2184x1690. 45° FOV: 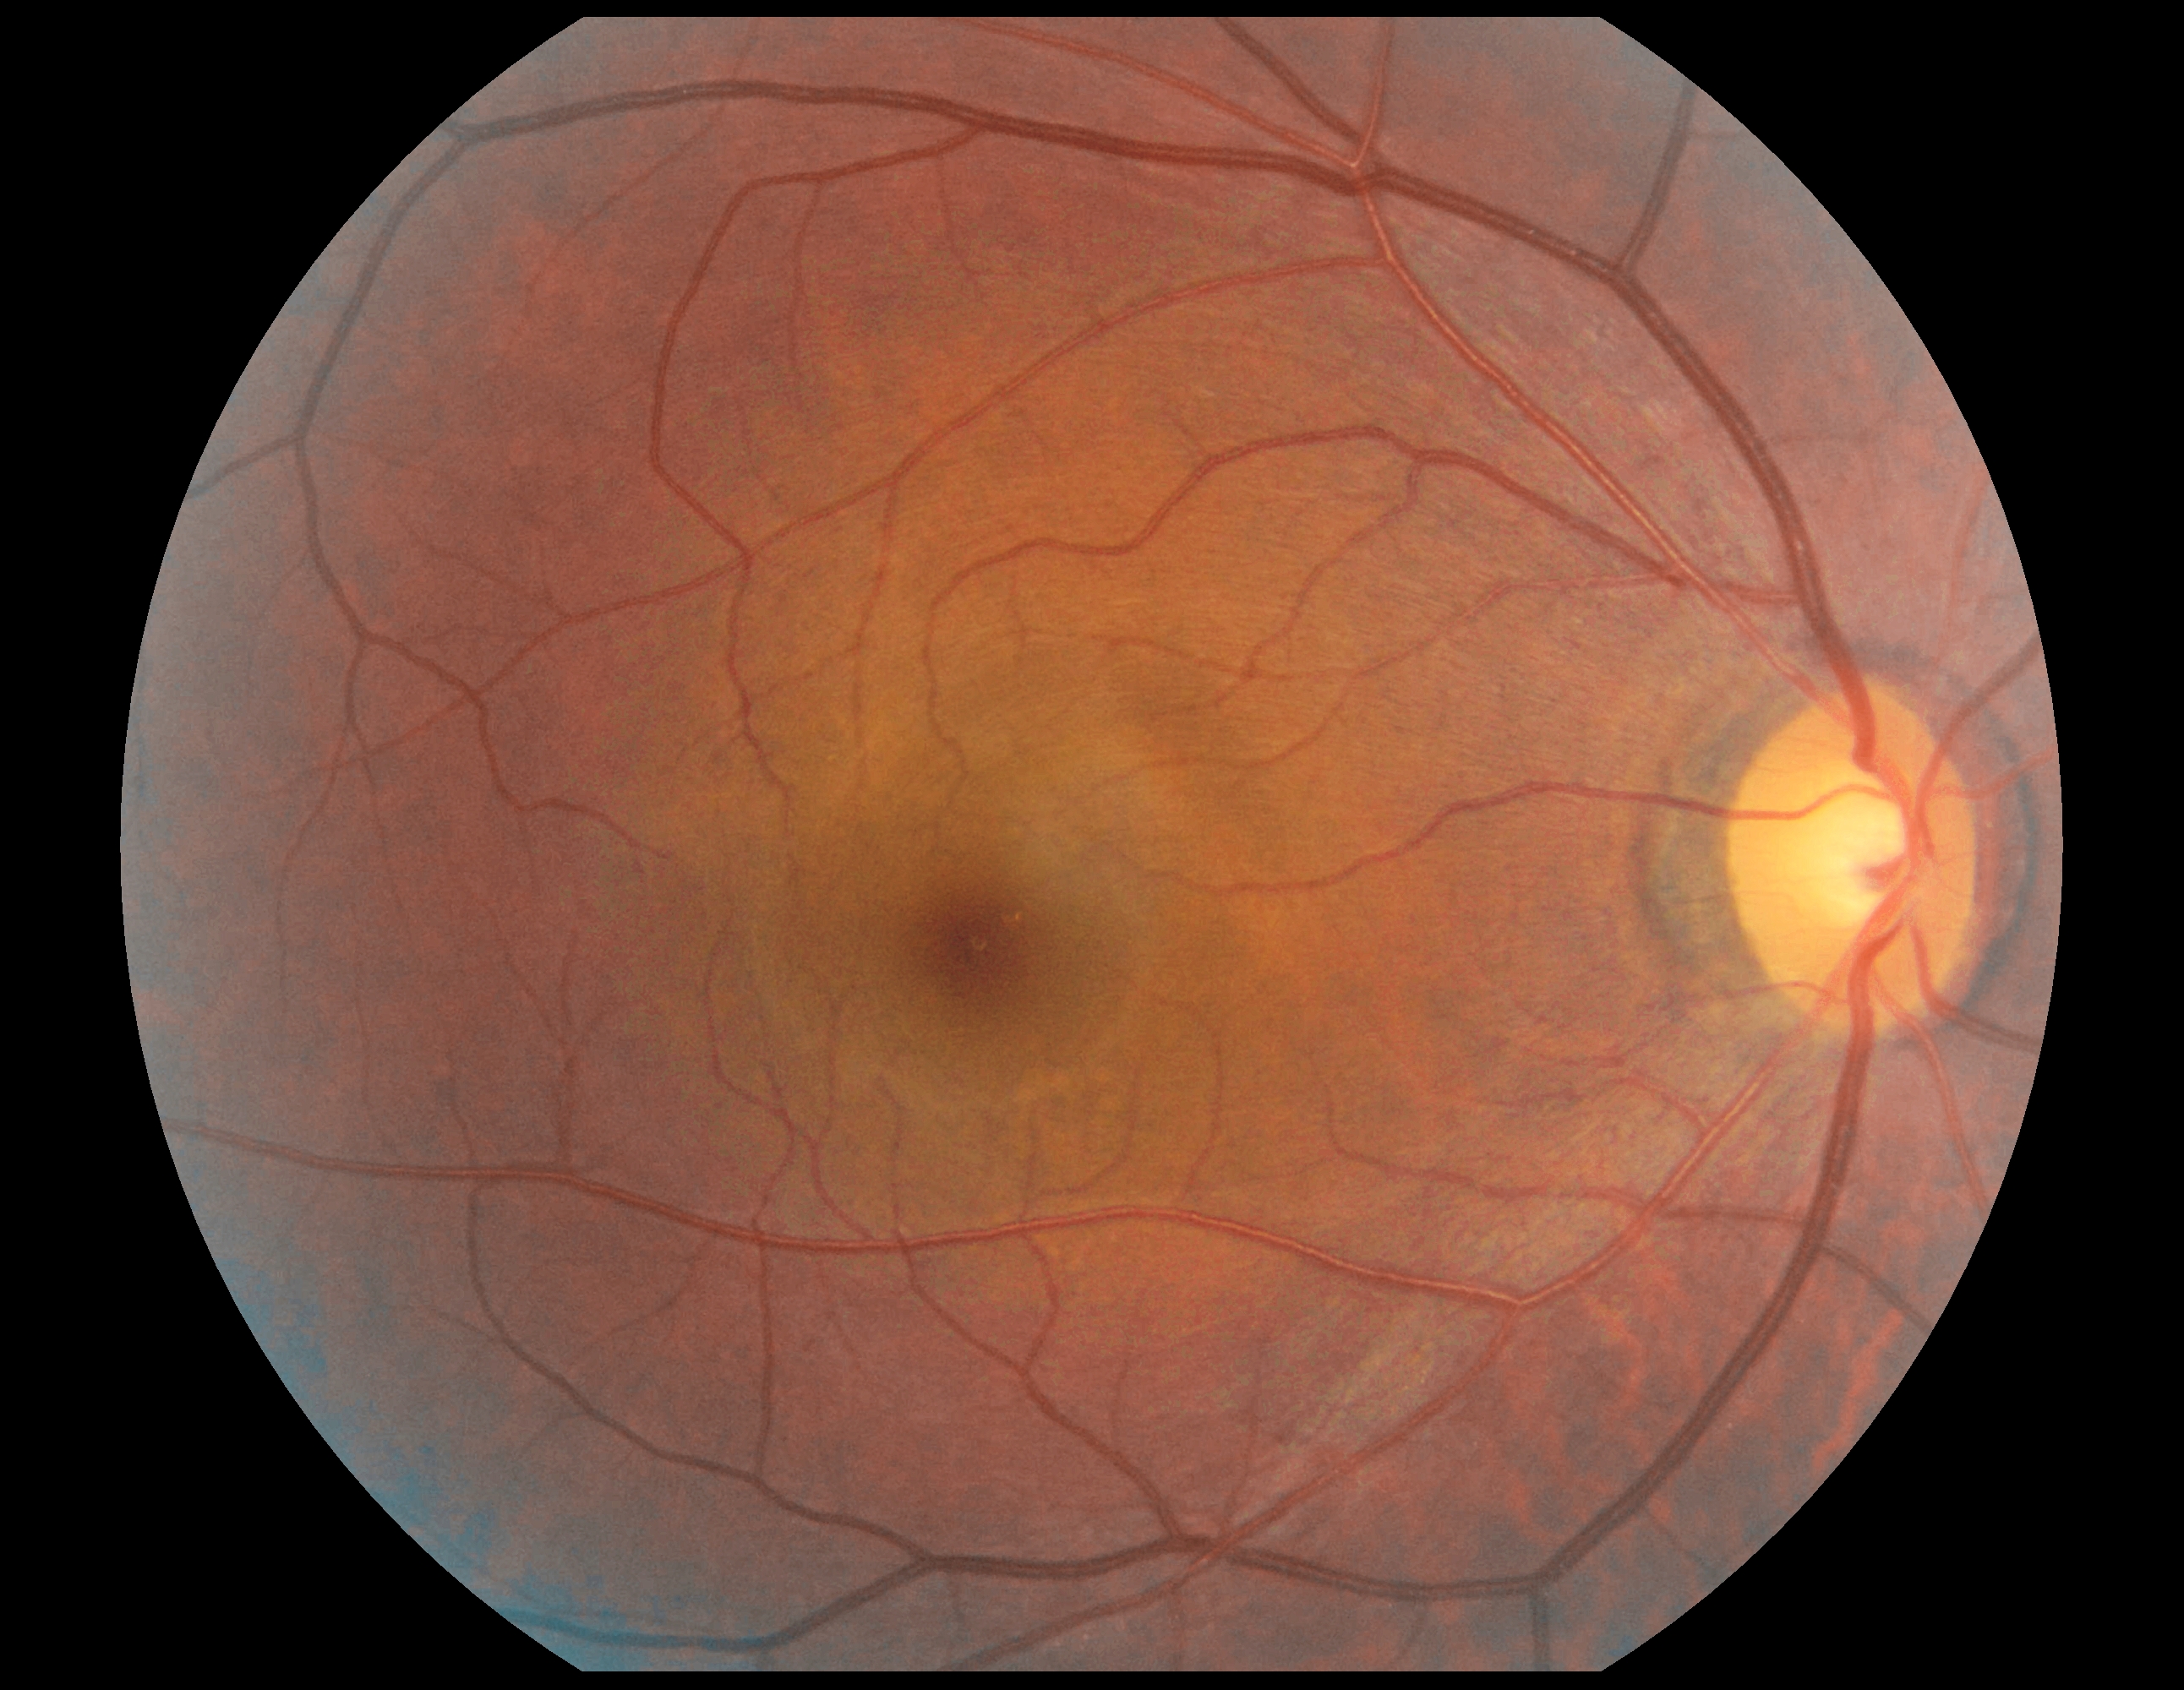

DR stage is grade 0 (no apparent retinopathy) — no visible signs of diabetic retinopathy.